45° FOV · no pharmacologic dilation · diabetic retinopathy graded by the modified Davis classification · NIDEK AFC-230 fundus camera: 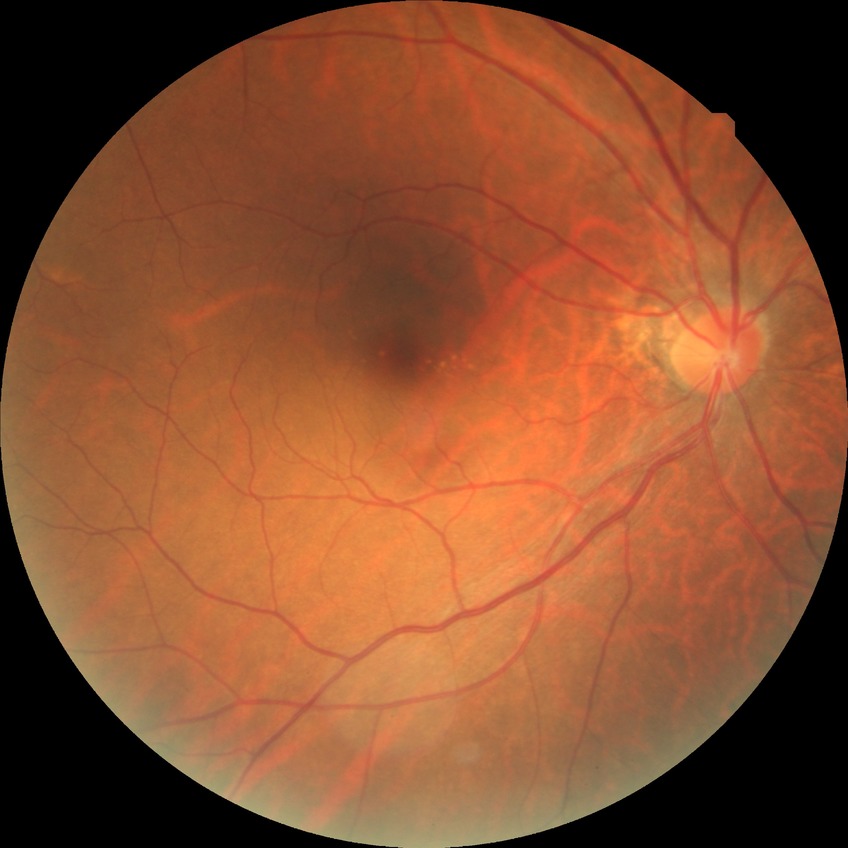 Davis stage is NDR.